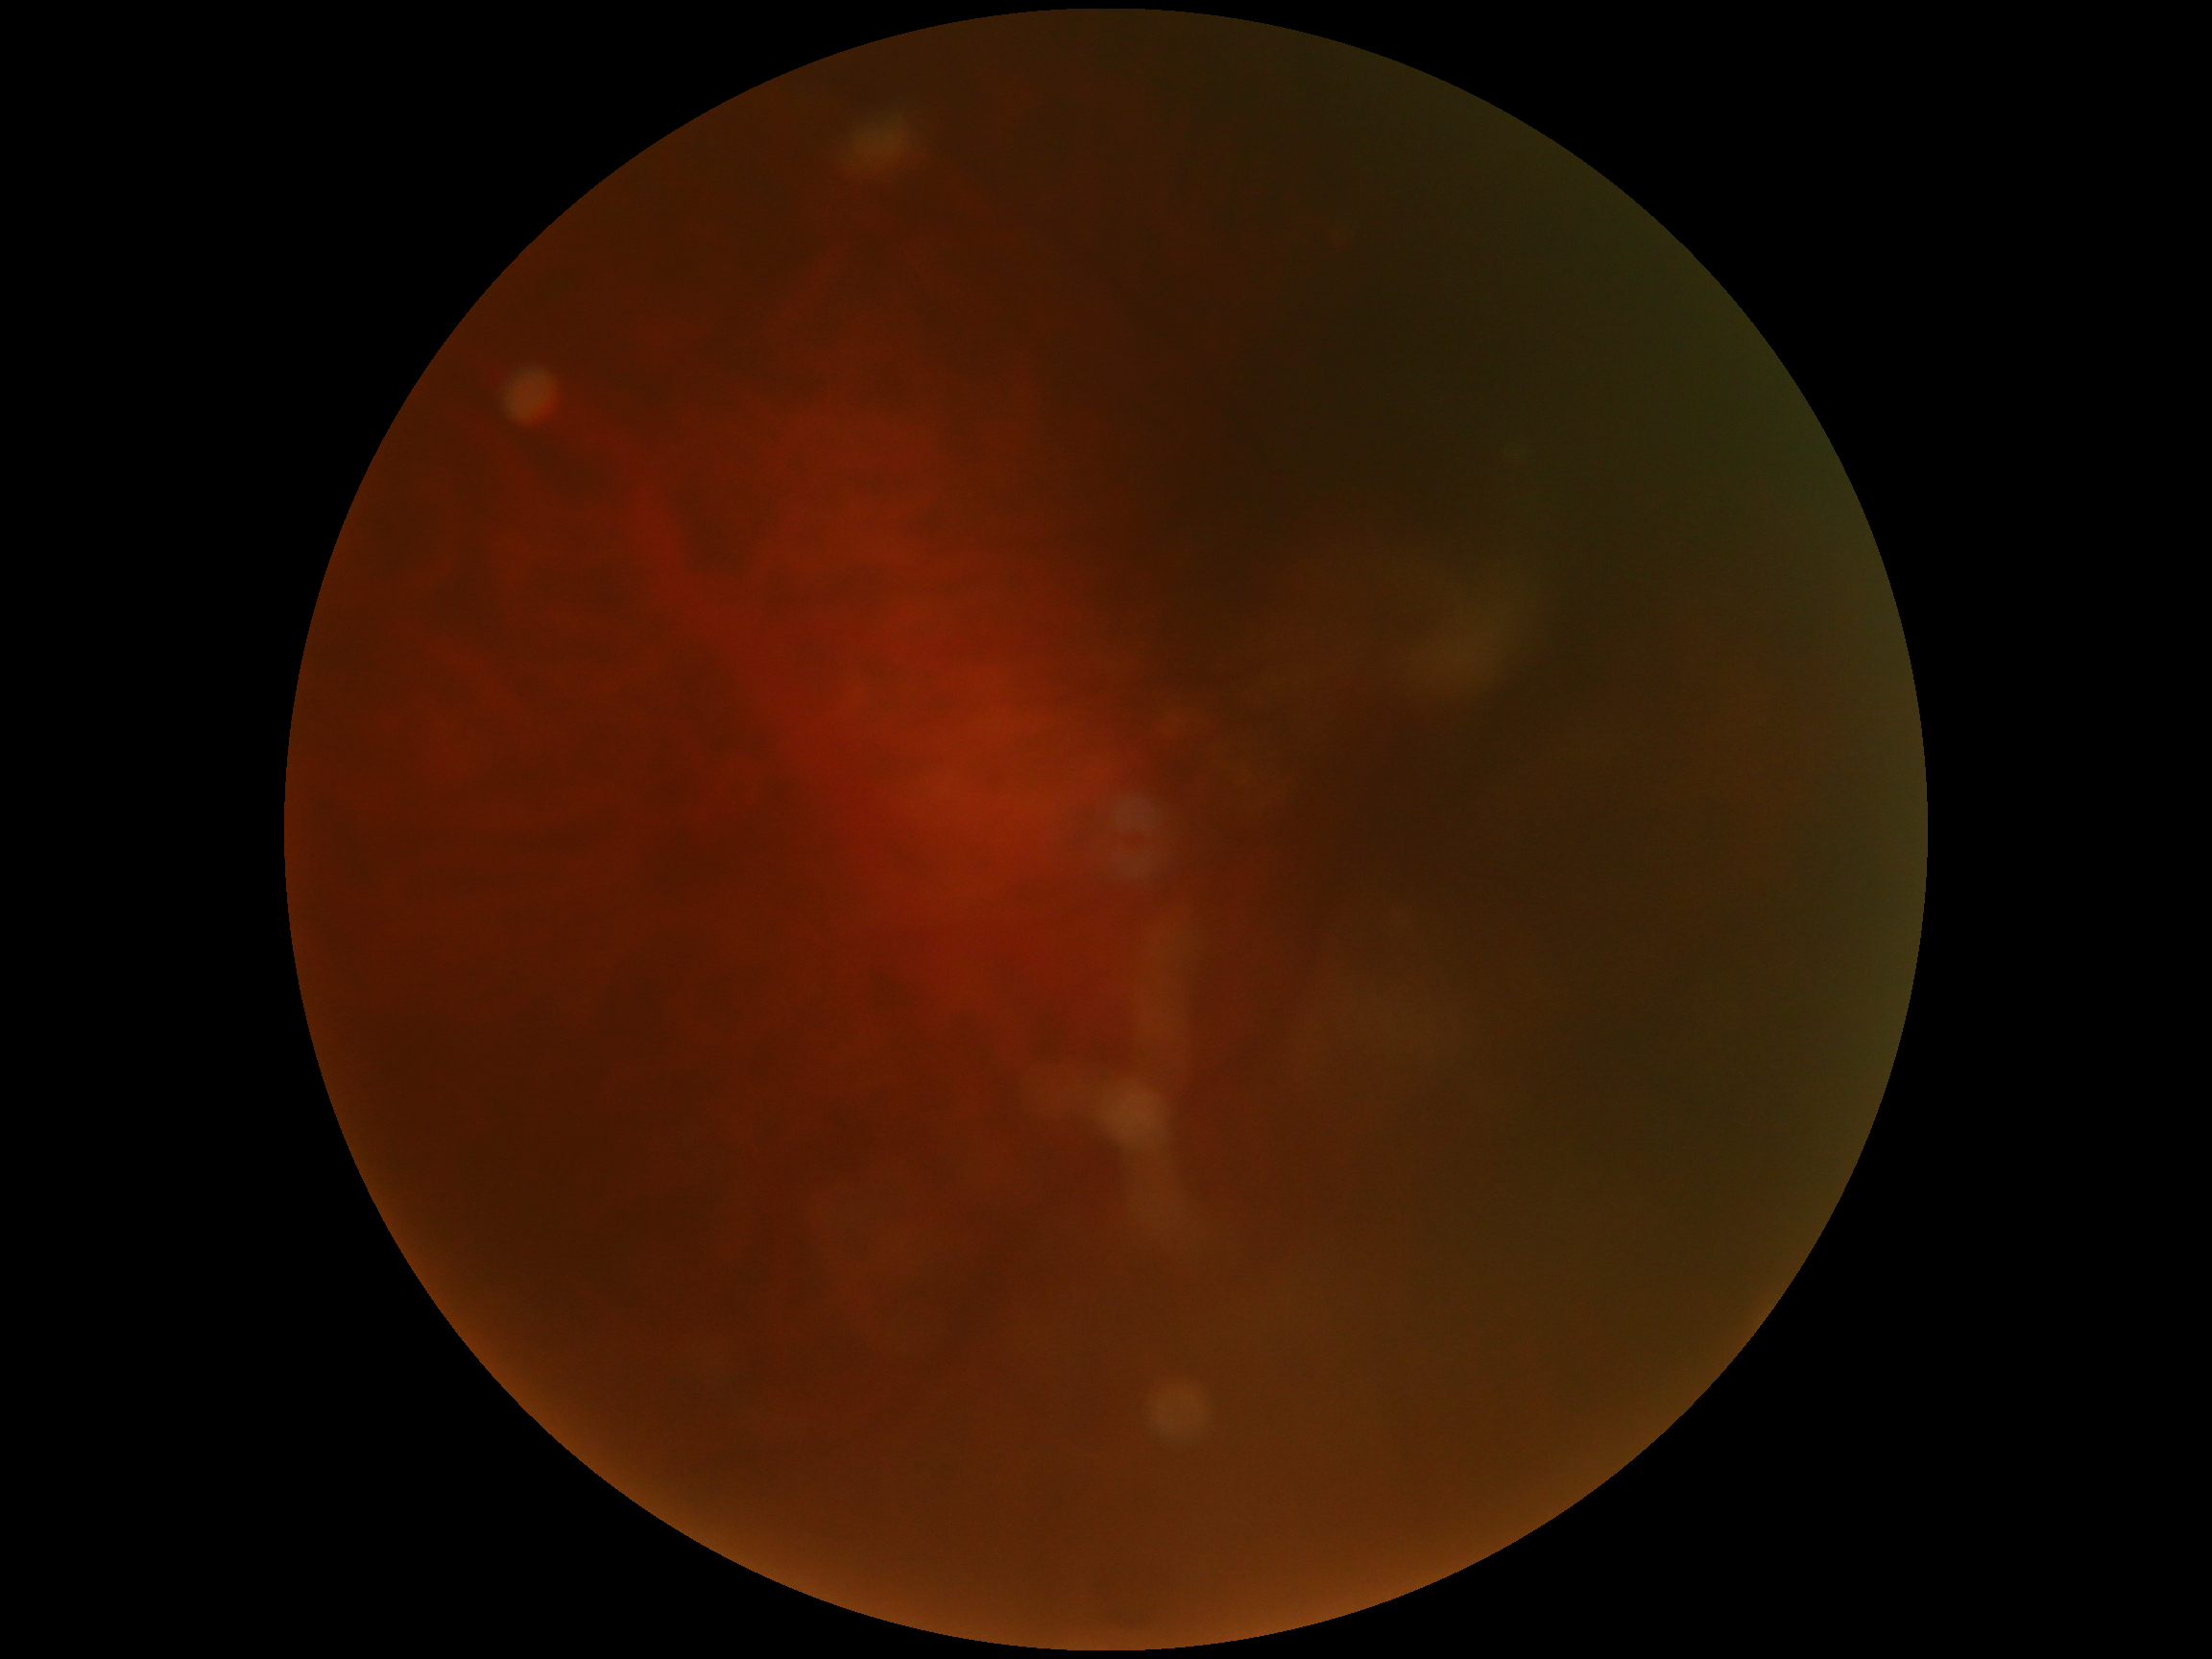
– DR stage — ungradable due to poor image quality
– image quality — below grading threshold